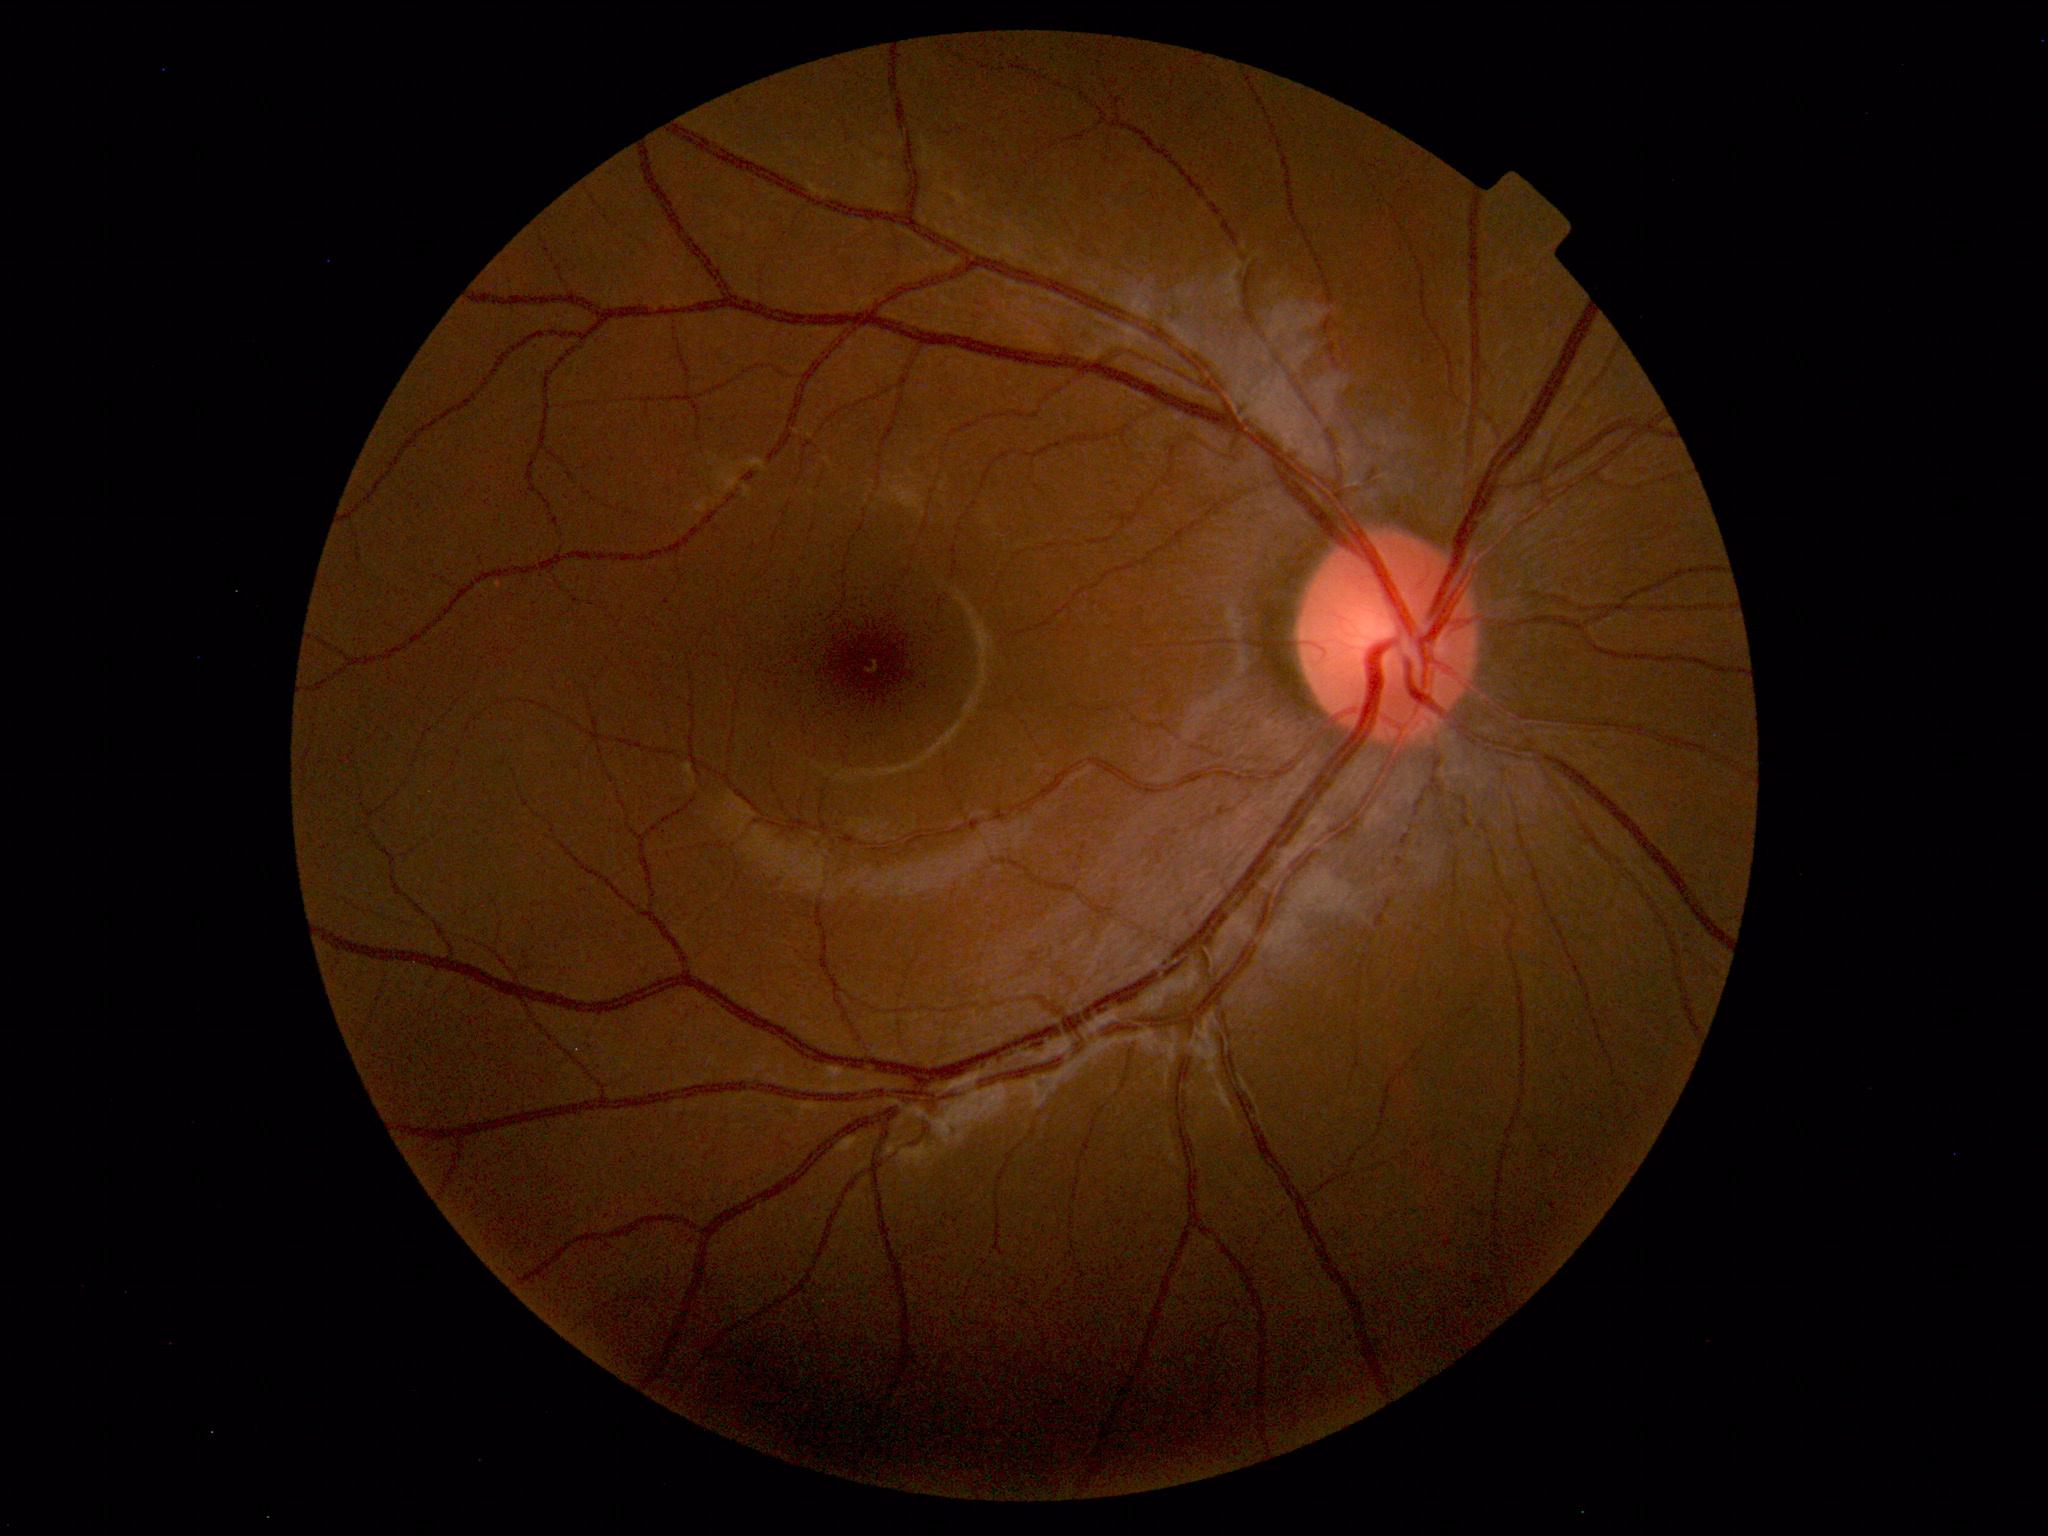

Normal fundus appearance.